640 by 480 pixels · wide-field fundus photograph from neonatal ROP screening — 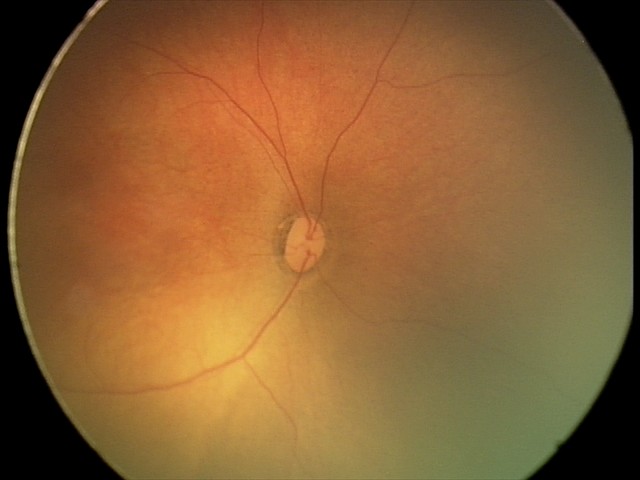

Assessment: normal fundus examination.